1240x1240px; Phoenix ICON, 100° FOV; pediatric wide-field fundus photograph
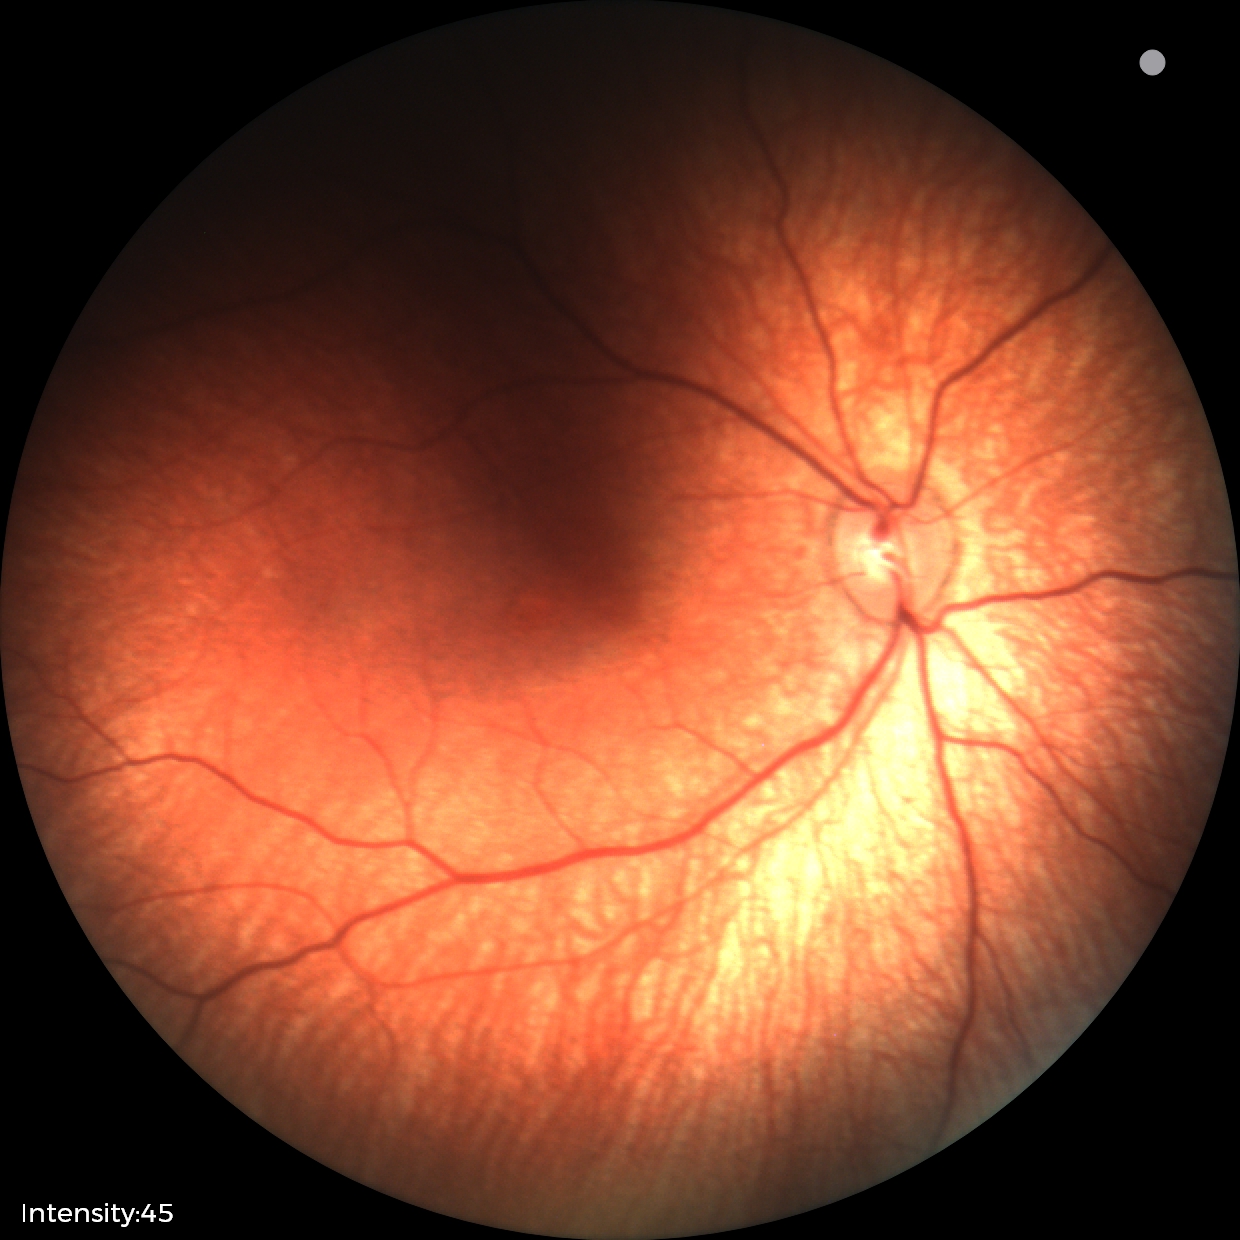
Screening examination with no abnormal retinal findings.